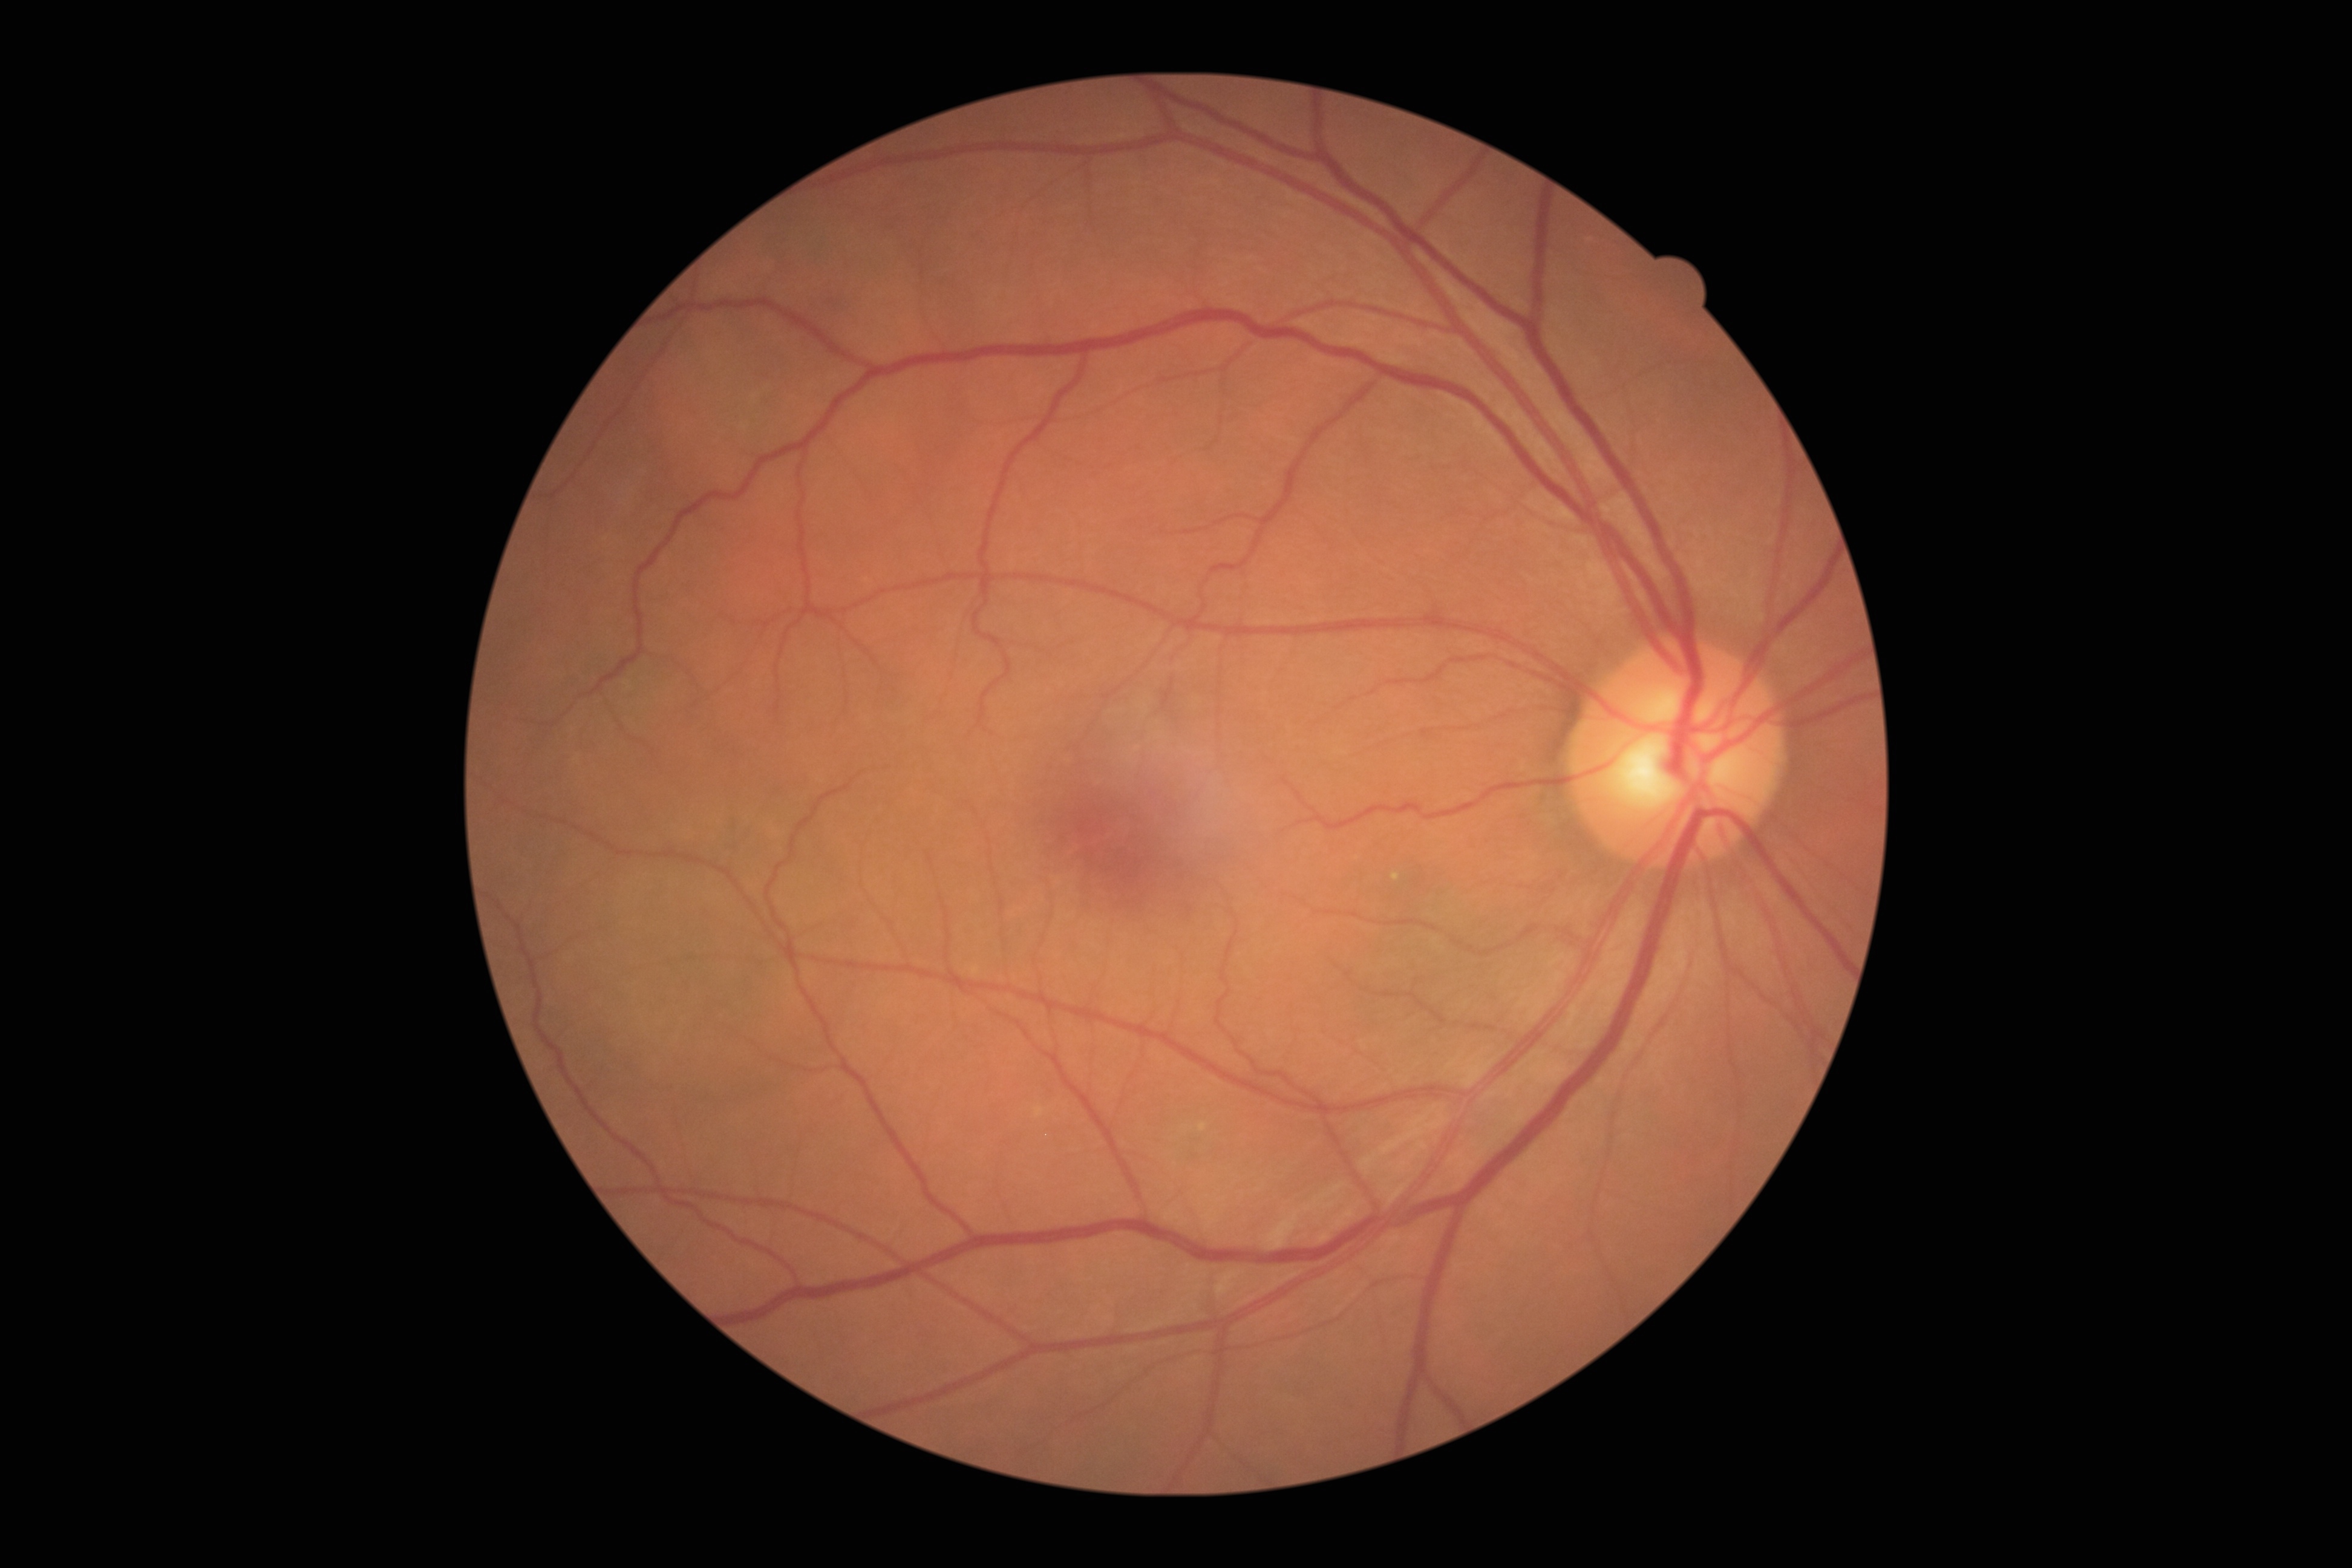 diabetic retinopathy severity: no apparent diabetic retinopathy (grade 0), DR impression: negative for DR.